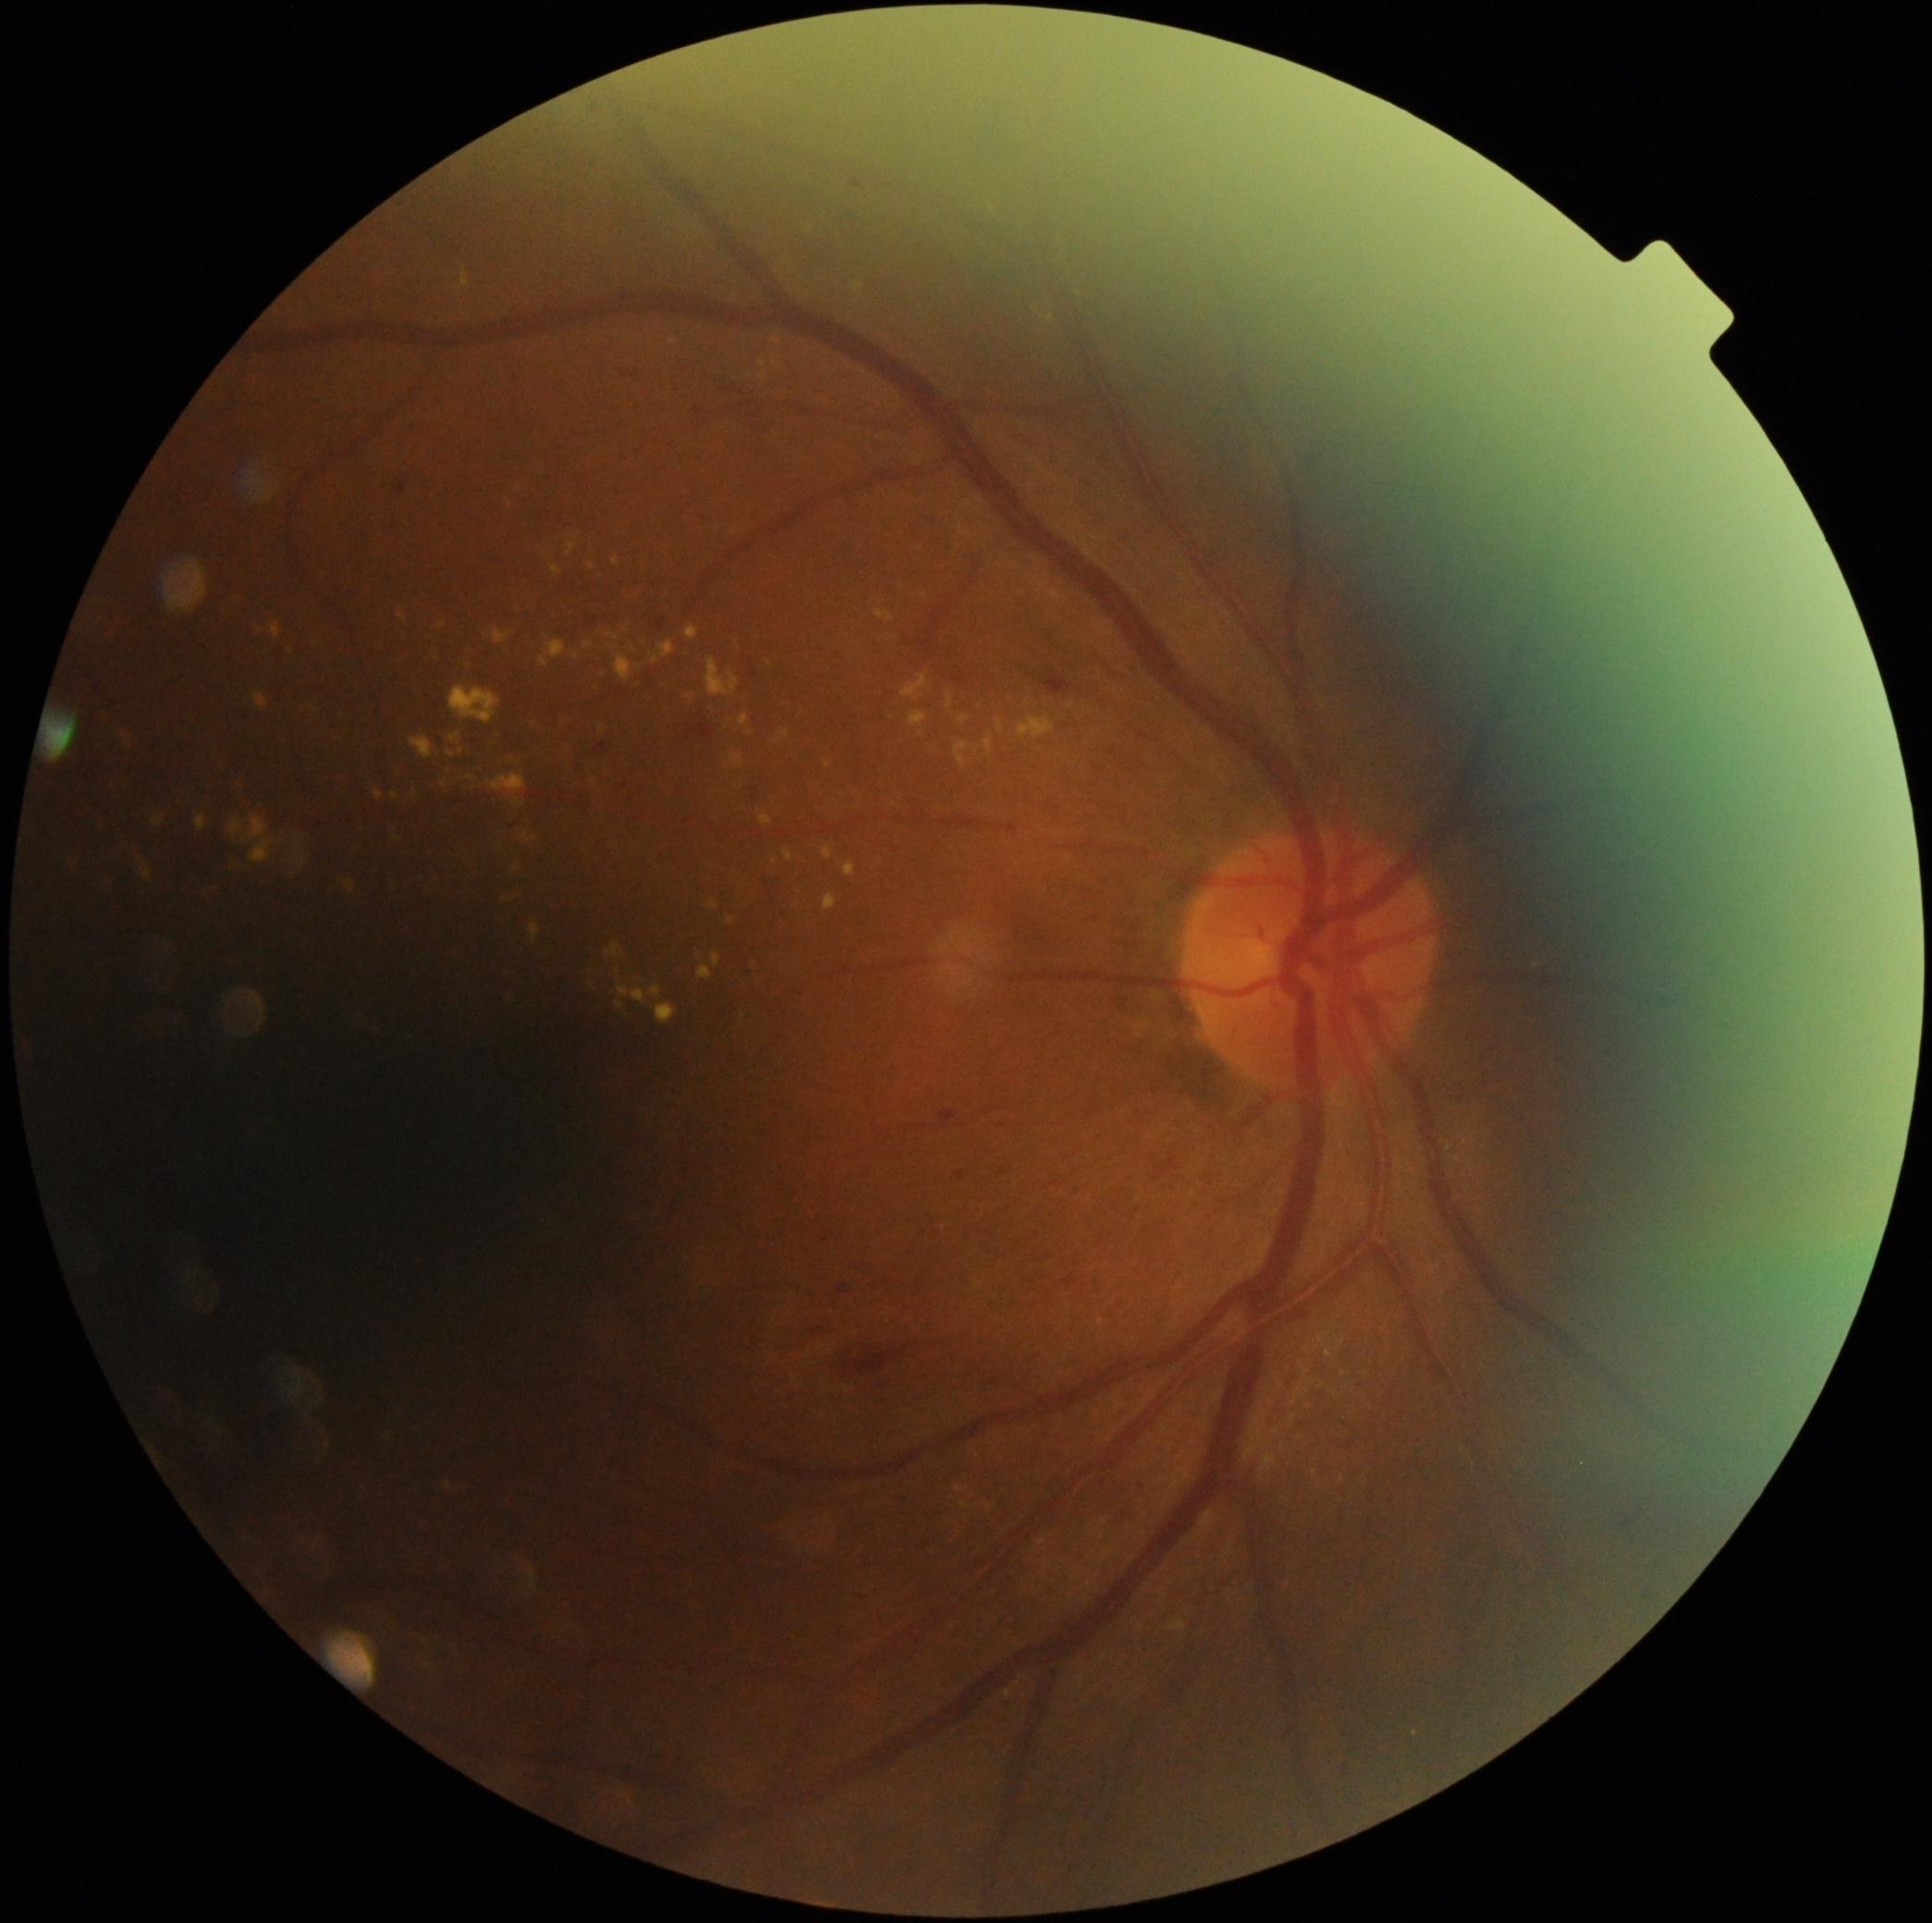

Diabetic retinopathy is grade 2 (moderate NPDR); non-proliferative diabetic retinopathy
Selected lesions:
- hard exudates (more not shown): Rect(410, 737, 434, 759); Rect(447, 750, 457, 757); Rect(825, 761, 830, 770); Rect(649, 986, 662, 1000); Rect(776, 729, 789, 742); Rect(199, 890, 214, 898); Rect(460, 1486, 468, 1491); Rect(215, 755, 230, 765); Rect(843, 862, 857, 877); Rect(909, 711, 927, 728); Rect(669, 337, 679, 347); Rect(1017, 715, 1055, 741); Rect(961, 1502, 969, 1511); Rect(630, 591, 642, 598); Rect(853, 281, 864, 292)
- Hard exudates (small, approximate centers) near [577, 657]; [578, 537]; [754, 963]; [517, 870]; [920, 549]